Wide-field fundus photograph of an infant. 640x480px. Acquired on the Clarity RetCam 3
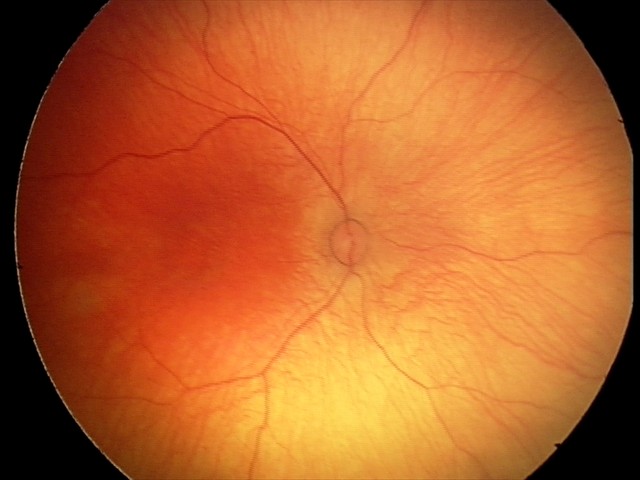
Screening diagnosis: physiological retinal finding.